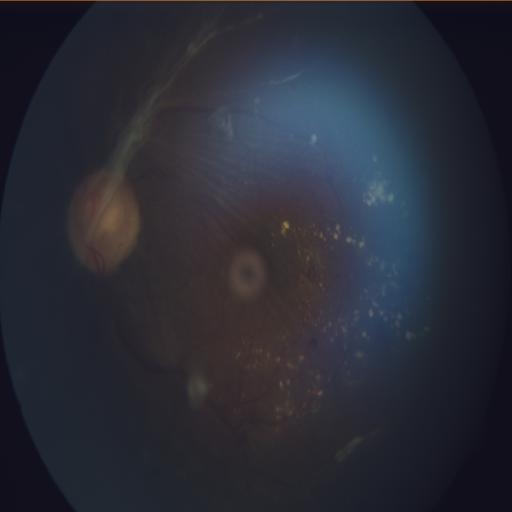
Abnormalities (4):
- retinal traction
- exudation
- macular edema
- choroidal folds